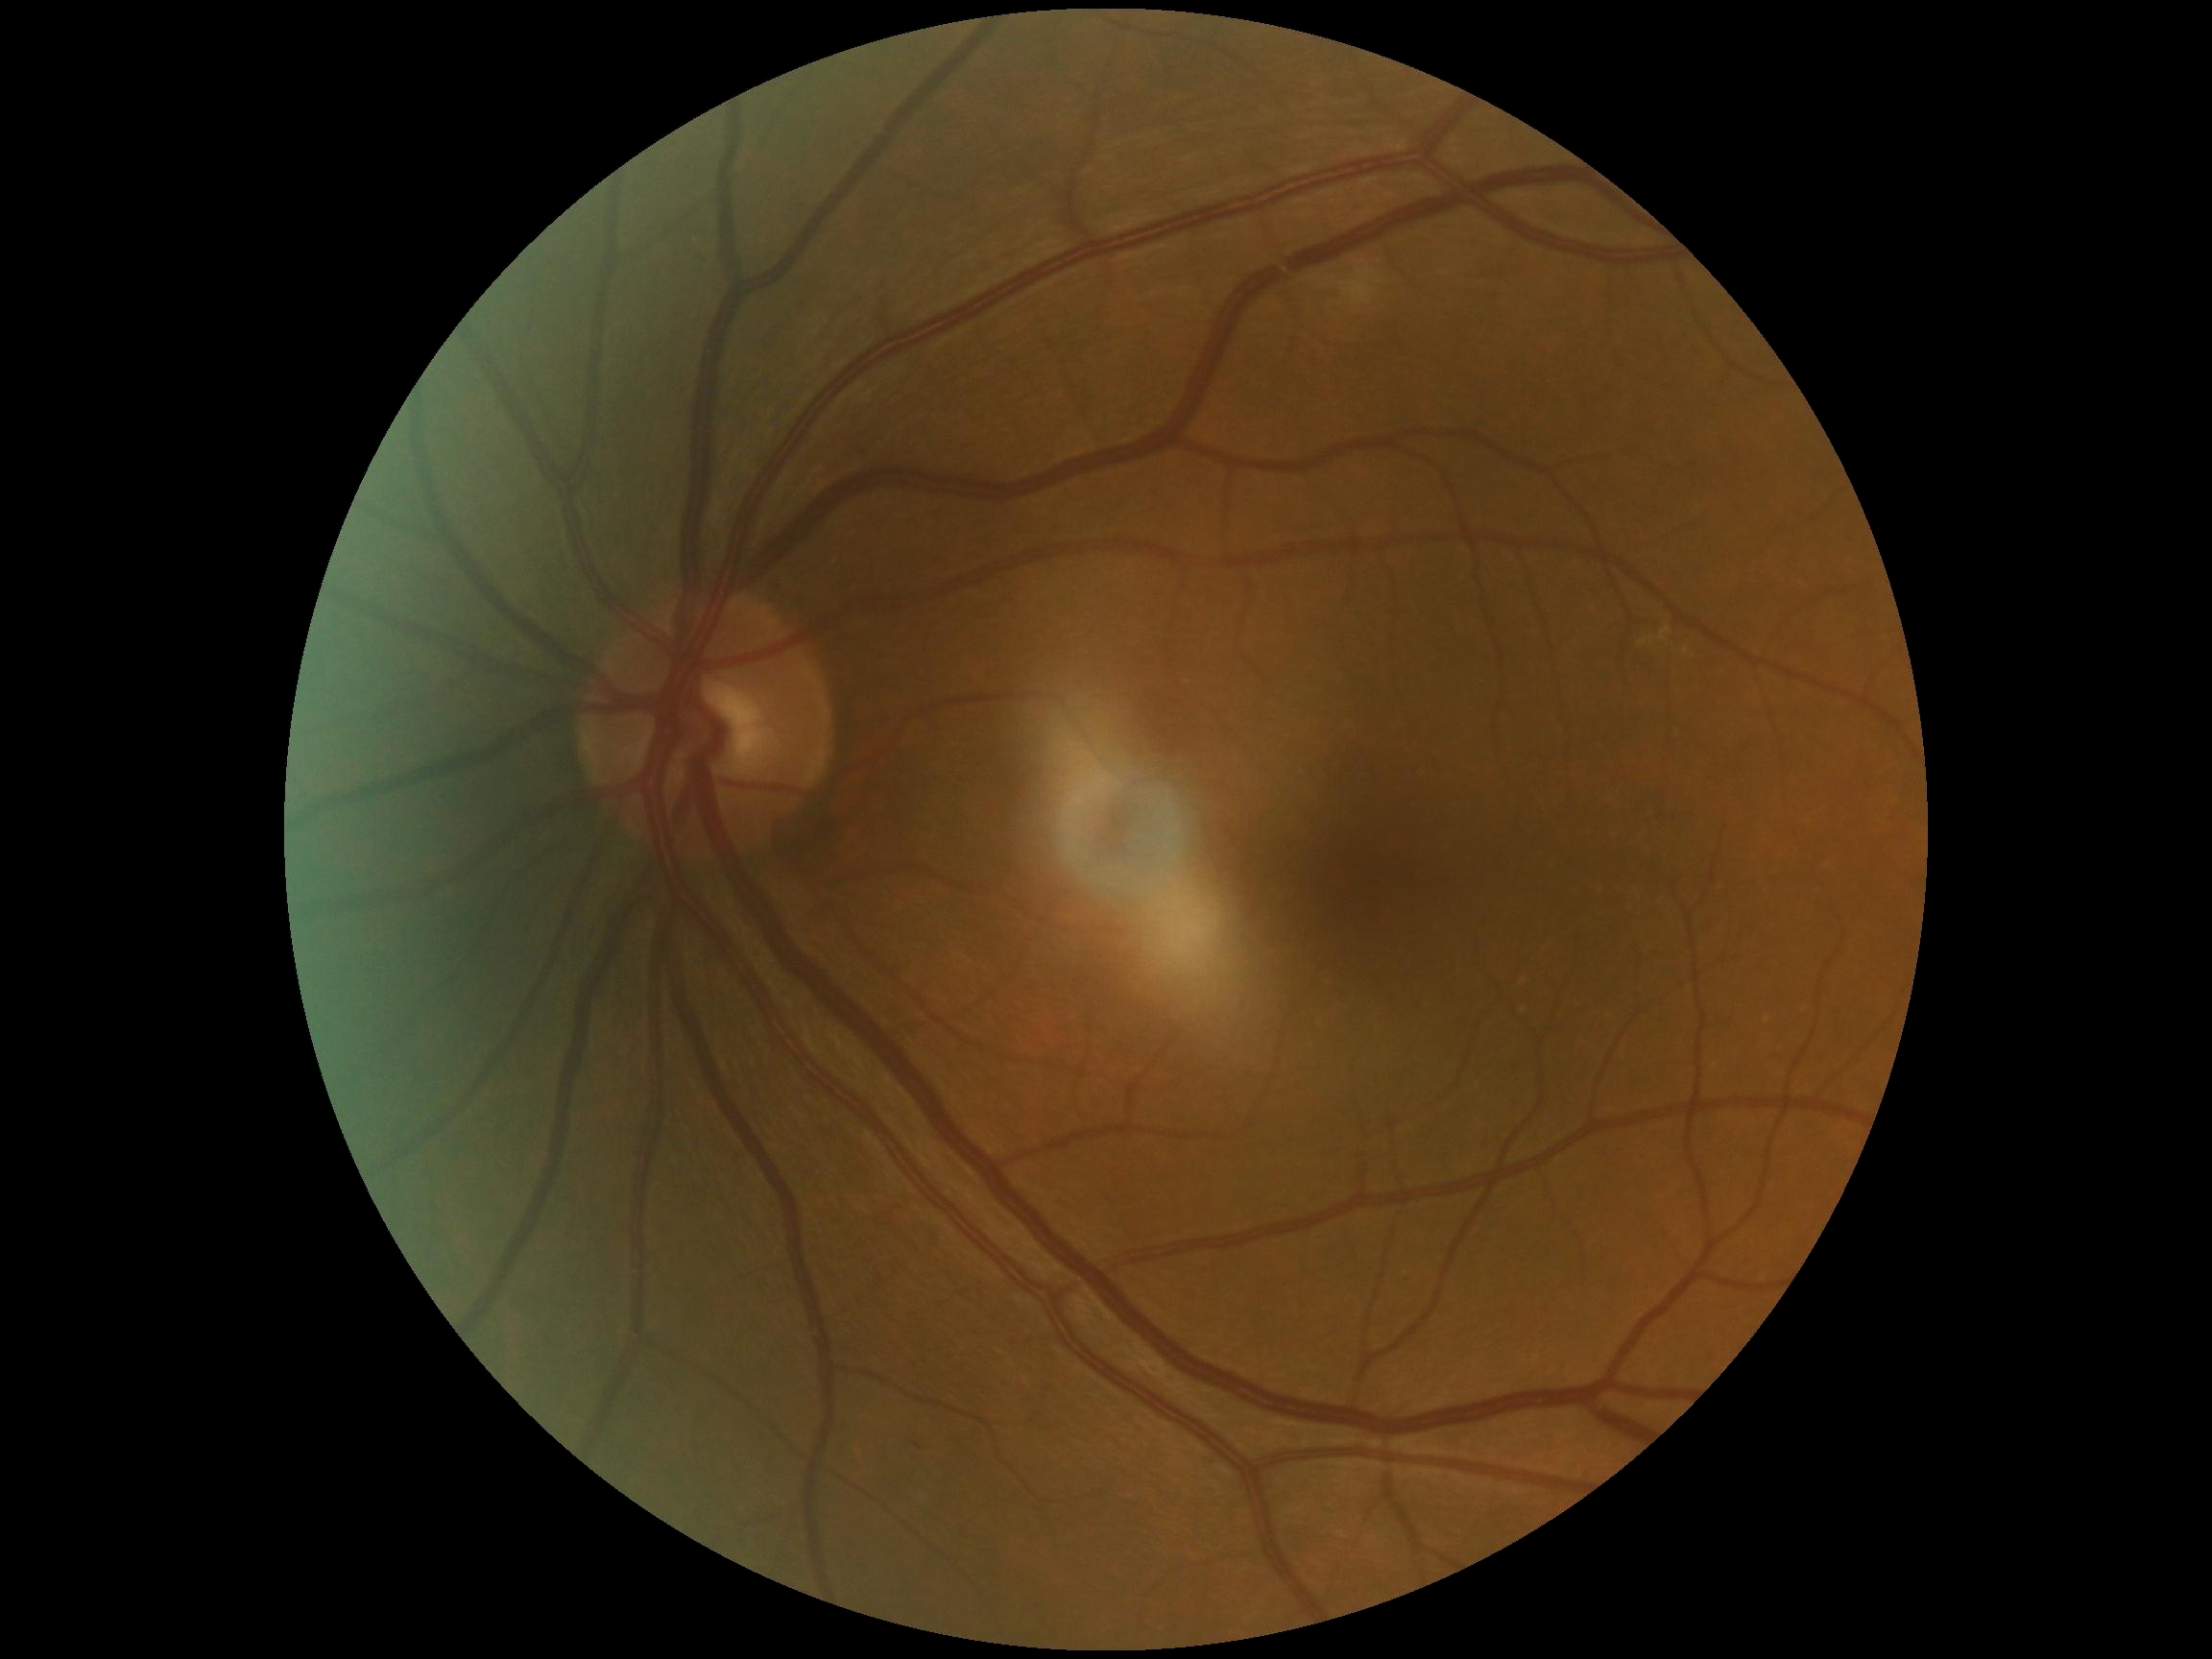
Retinopathy is no apparent diabetic retinopathy (grade 0).